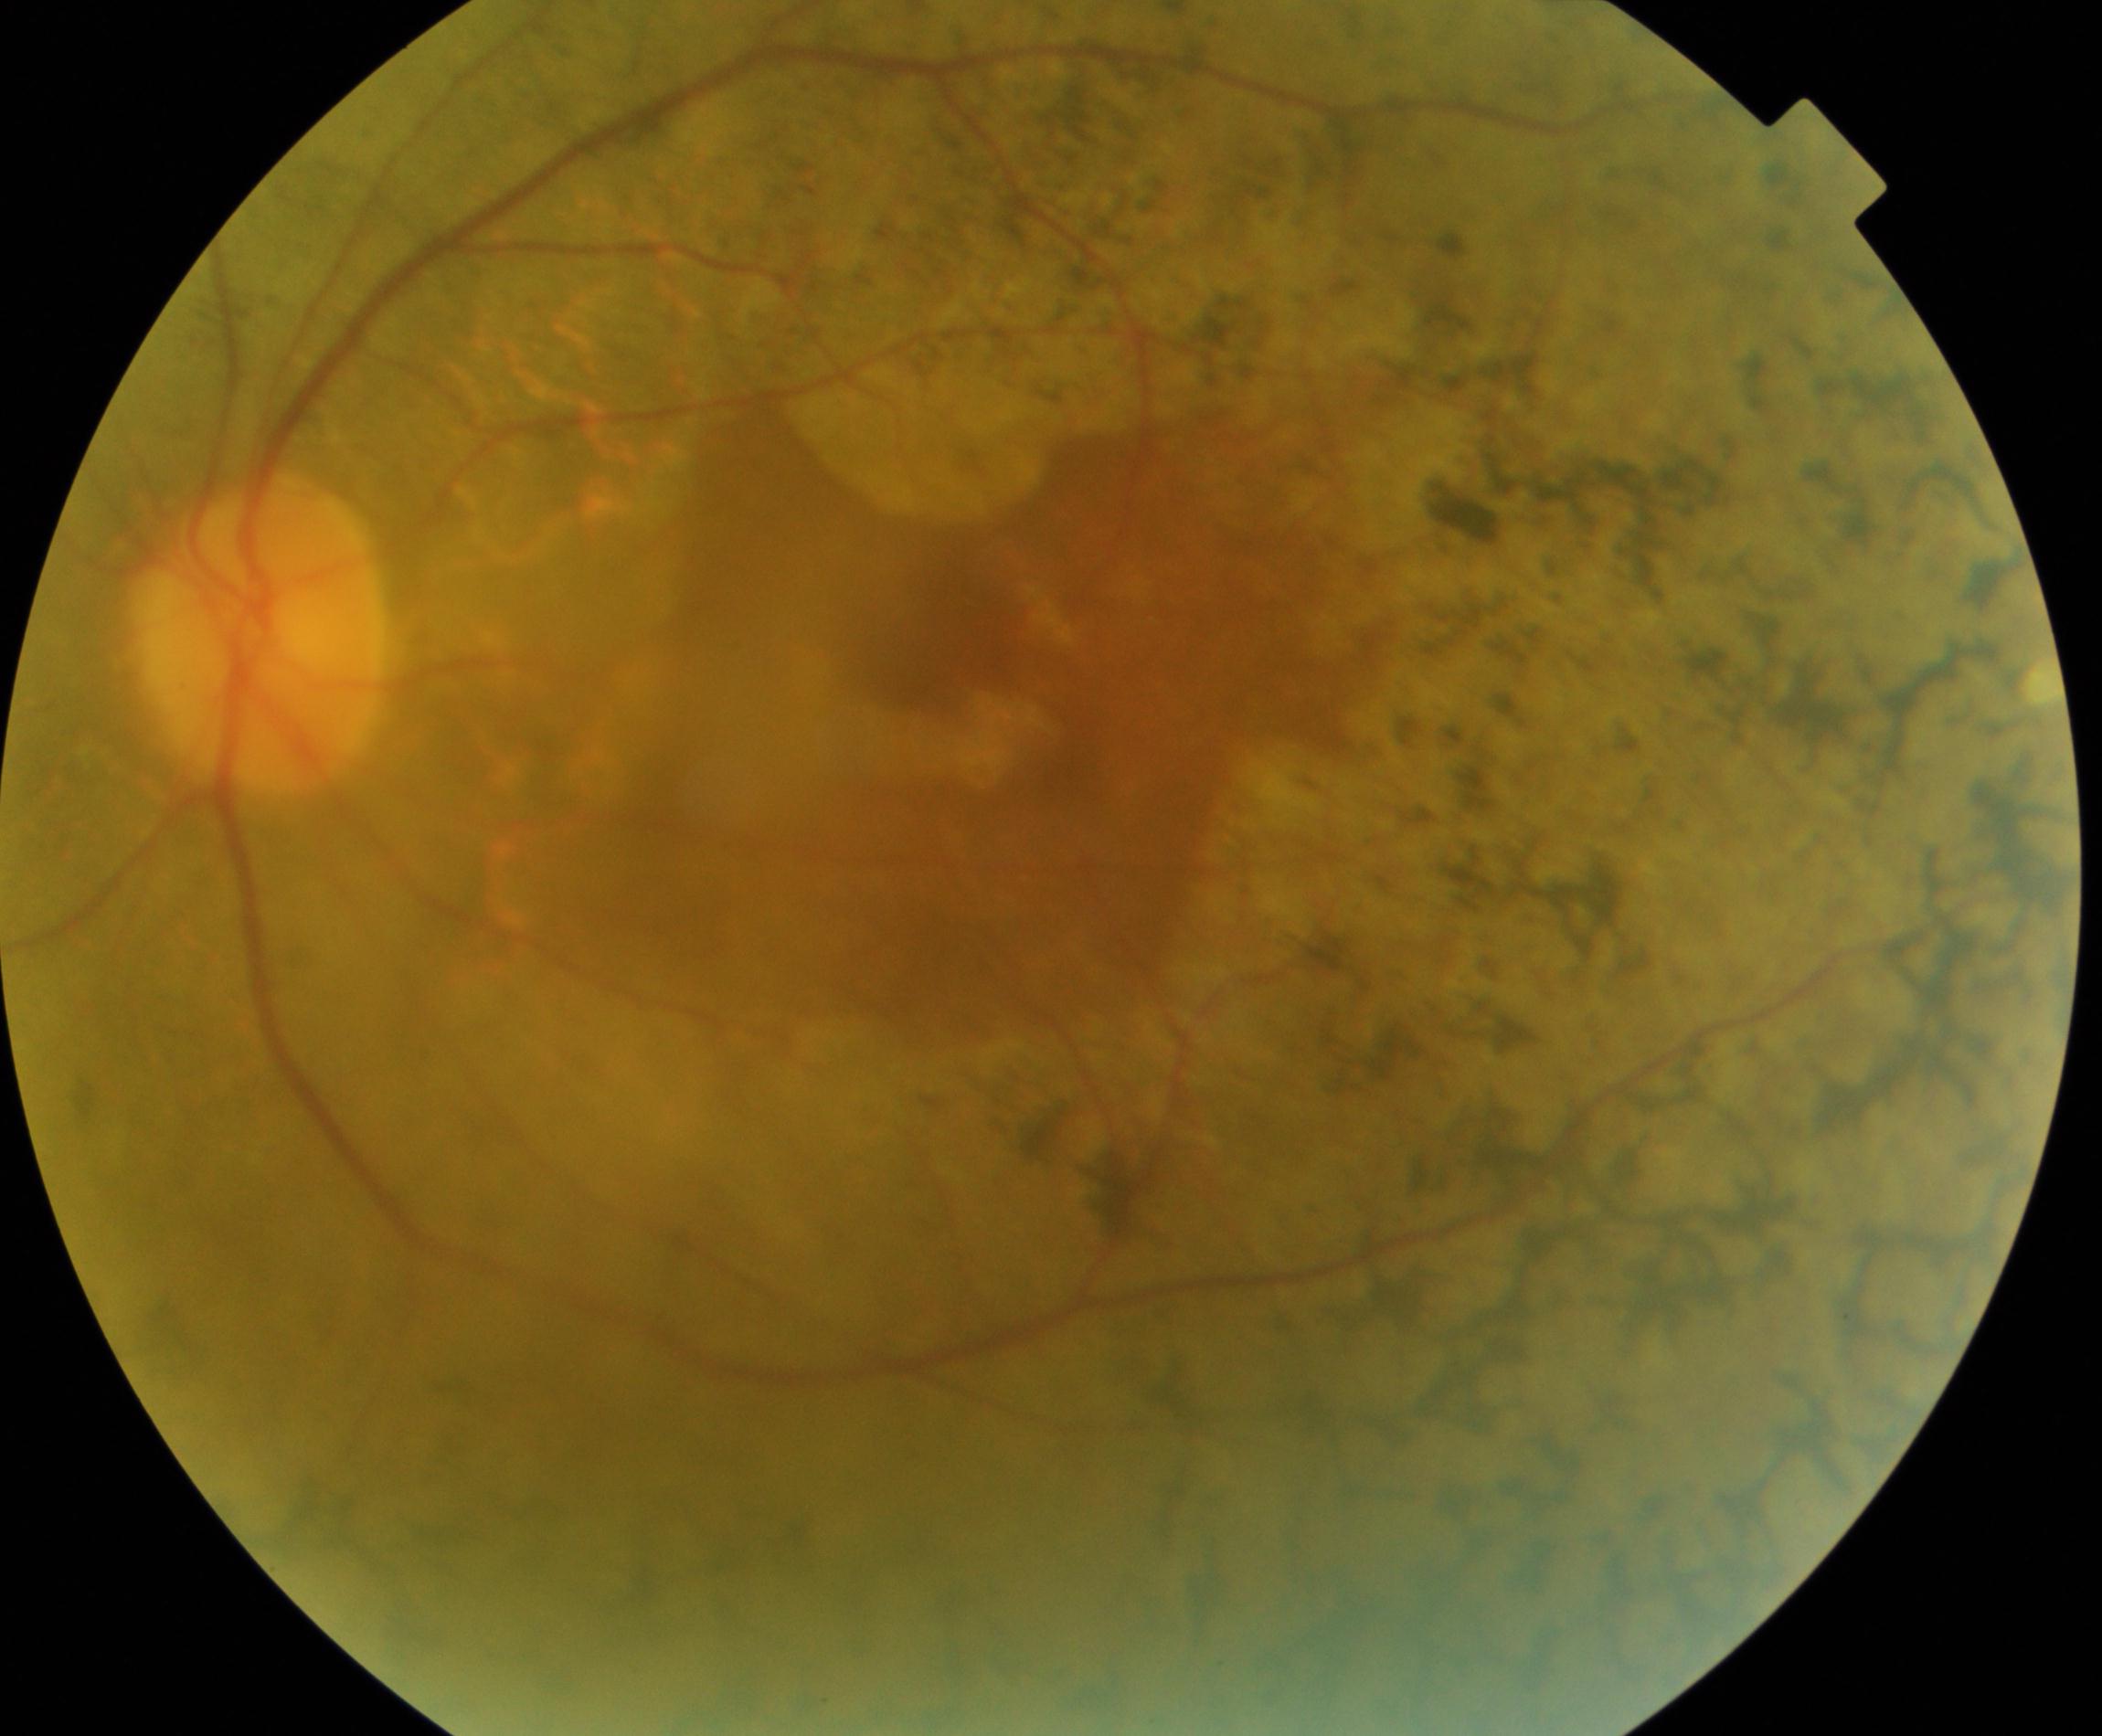 Demonstrates retinitis pigmentosa.